Central corneal thickness 592 µm.
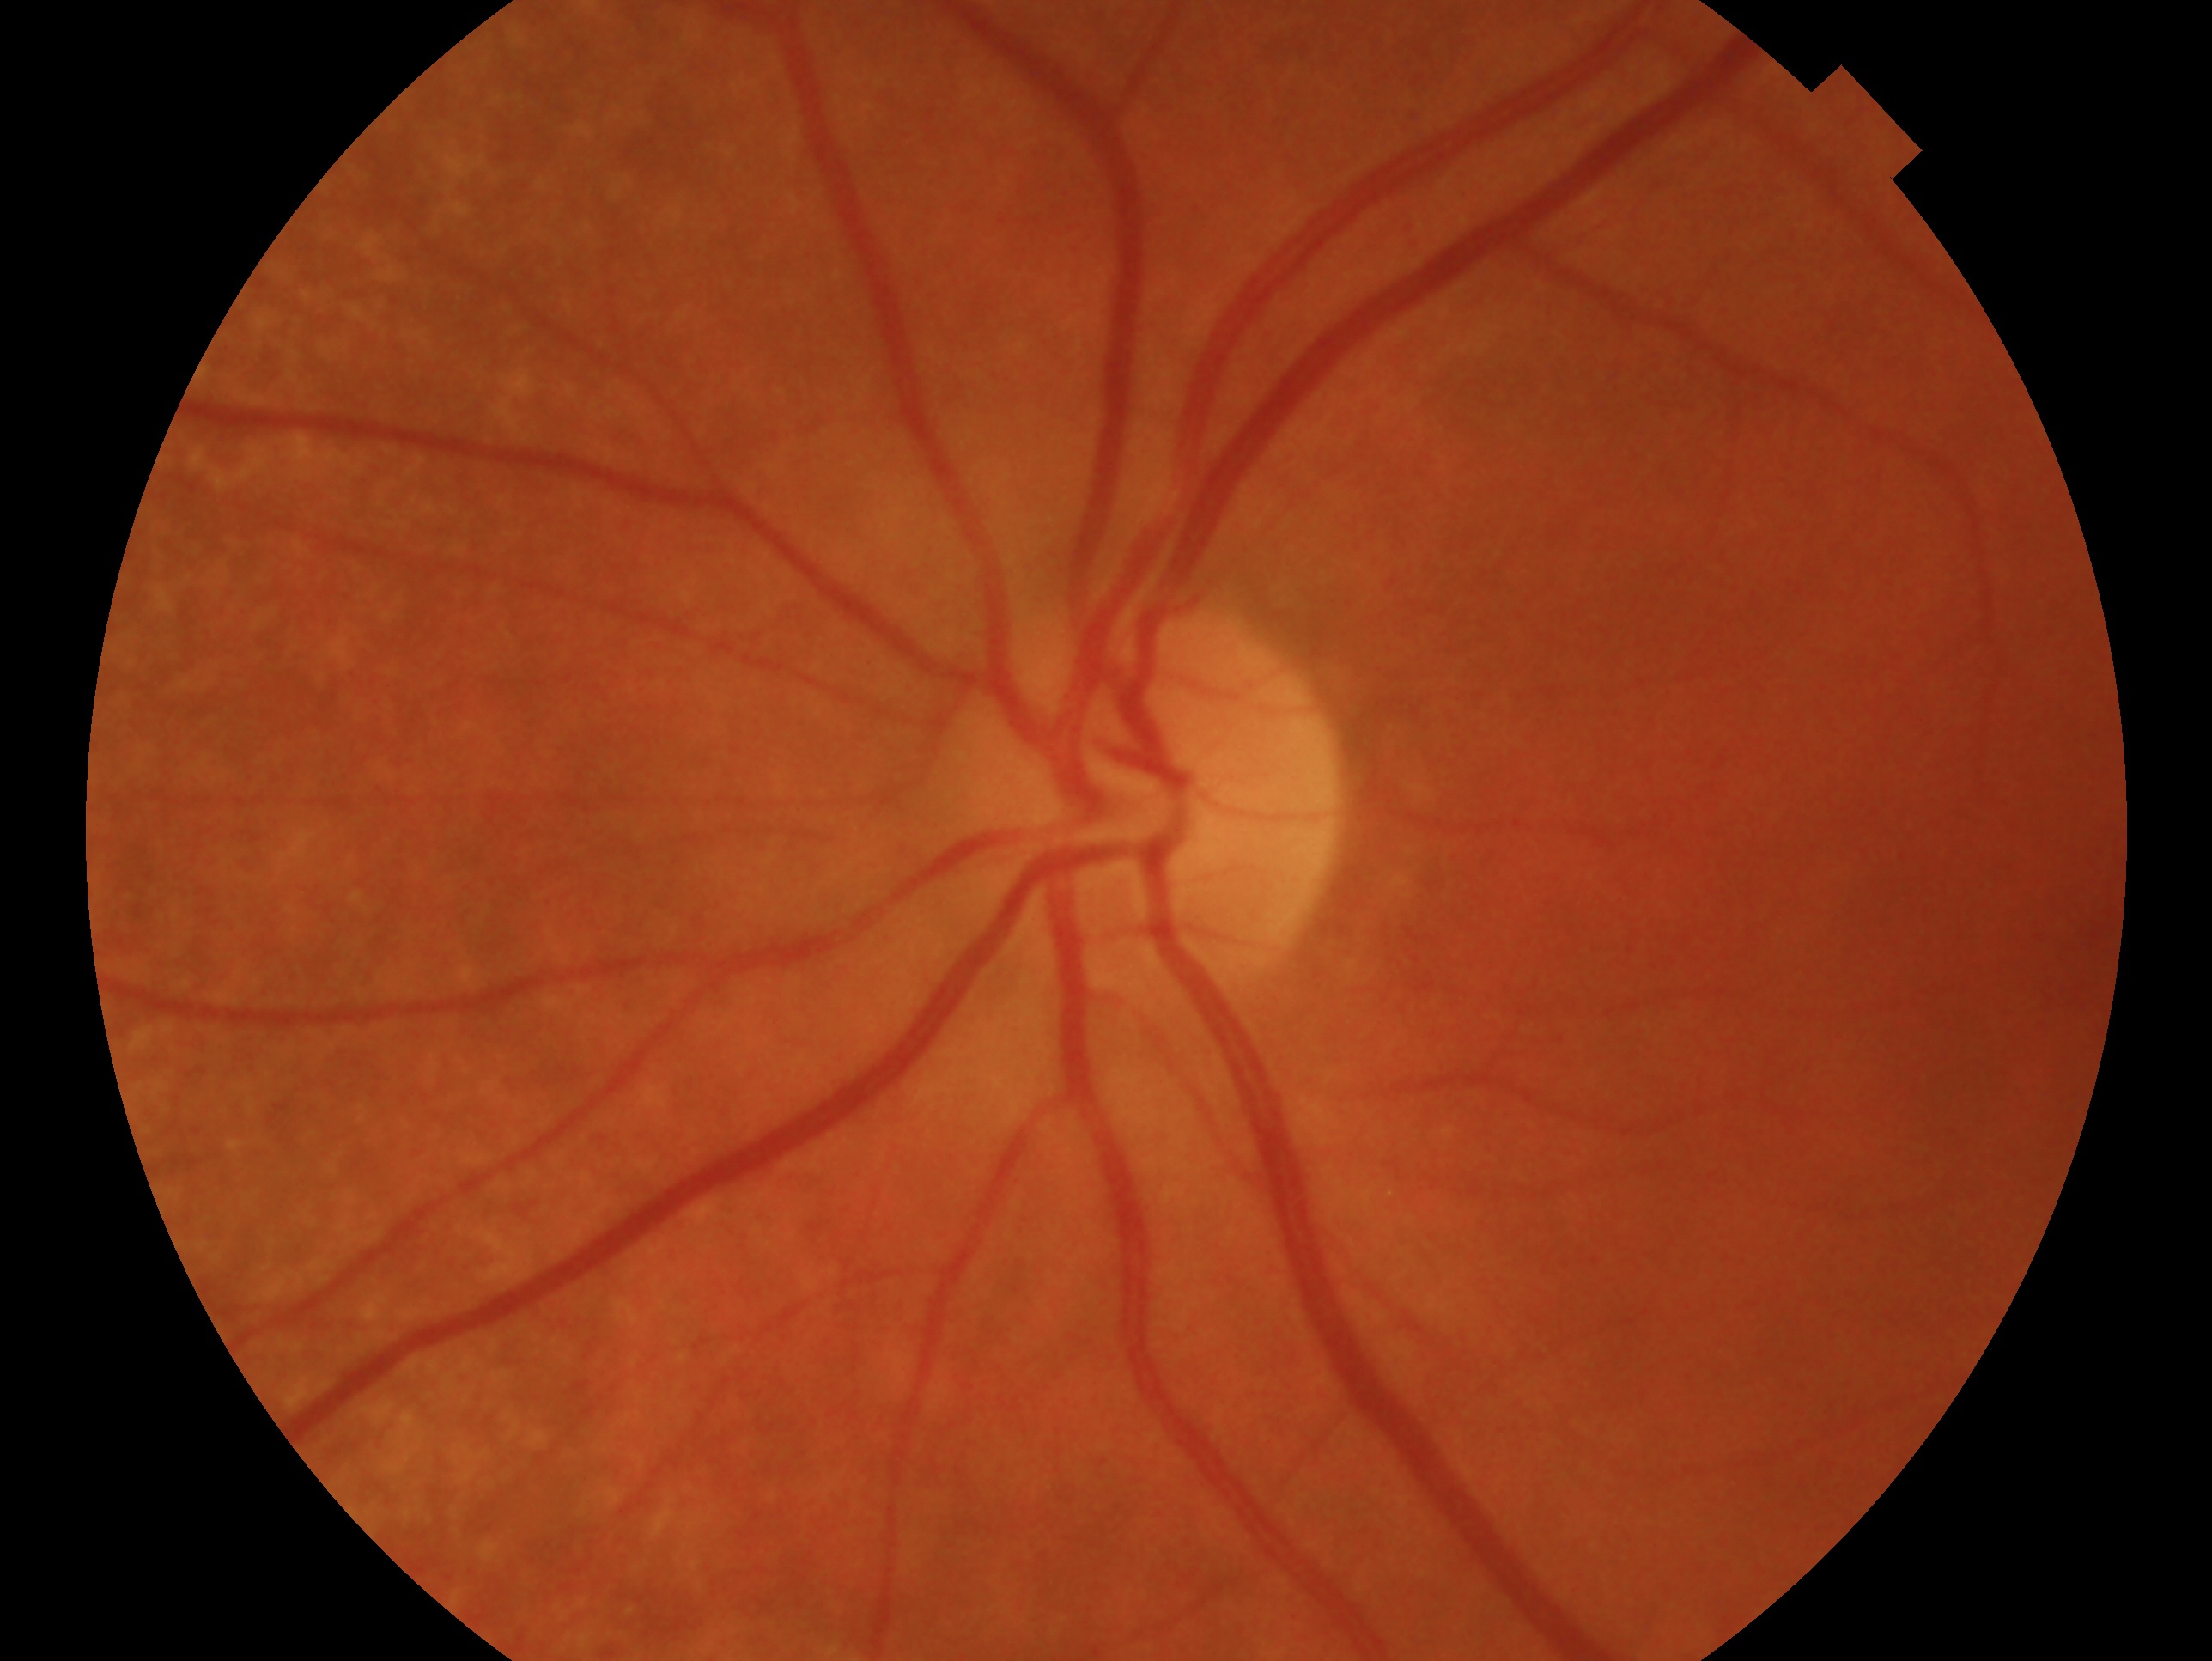

impression = negative for glaucoma
laterality = left eye